Modified Davis classification, color fundus image, nonmydriatic, 45 degree fundus photograph.
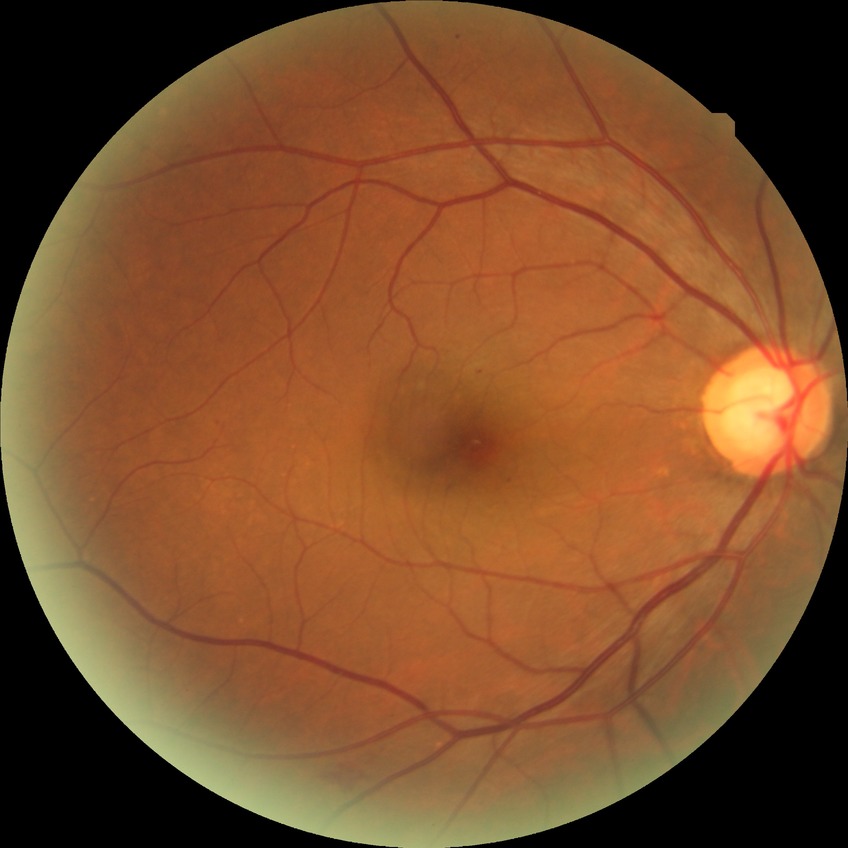

Diabetic retinopathy (DR): SDR (simple diabetic retinopathy).